Camera: NIDEK AFC-230 — 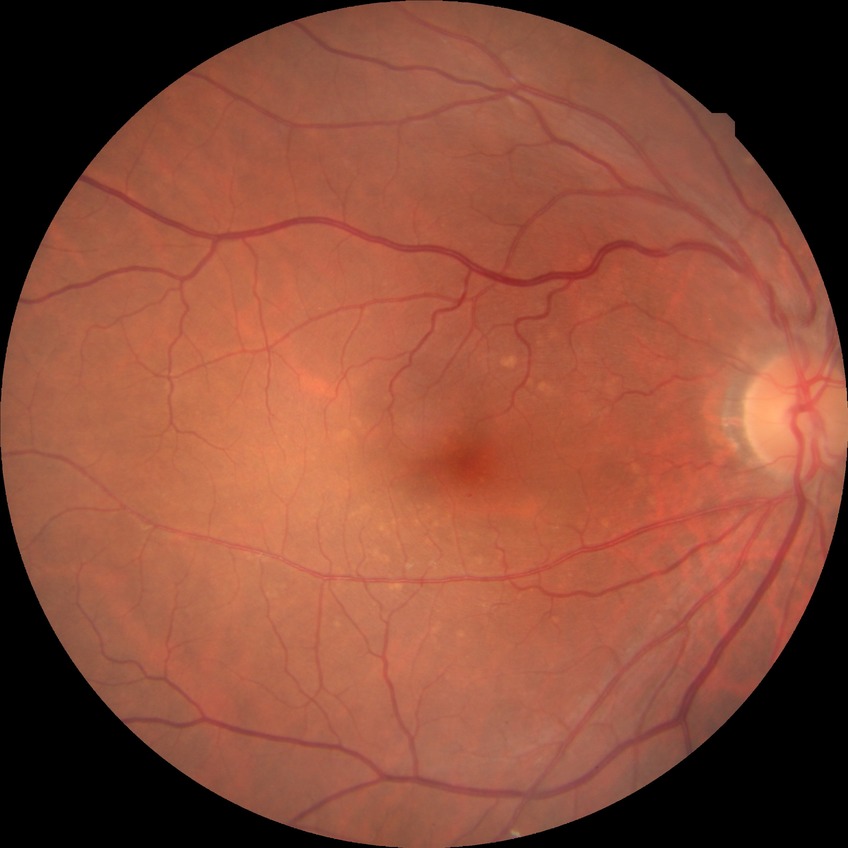
Retinopathy grade is no diabetic retinopathy.